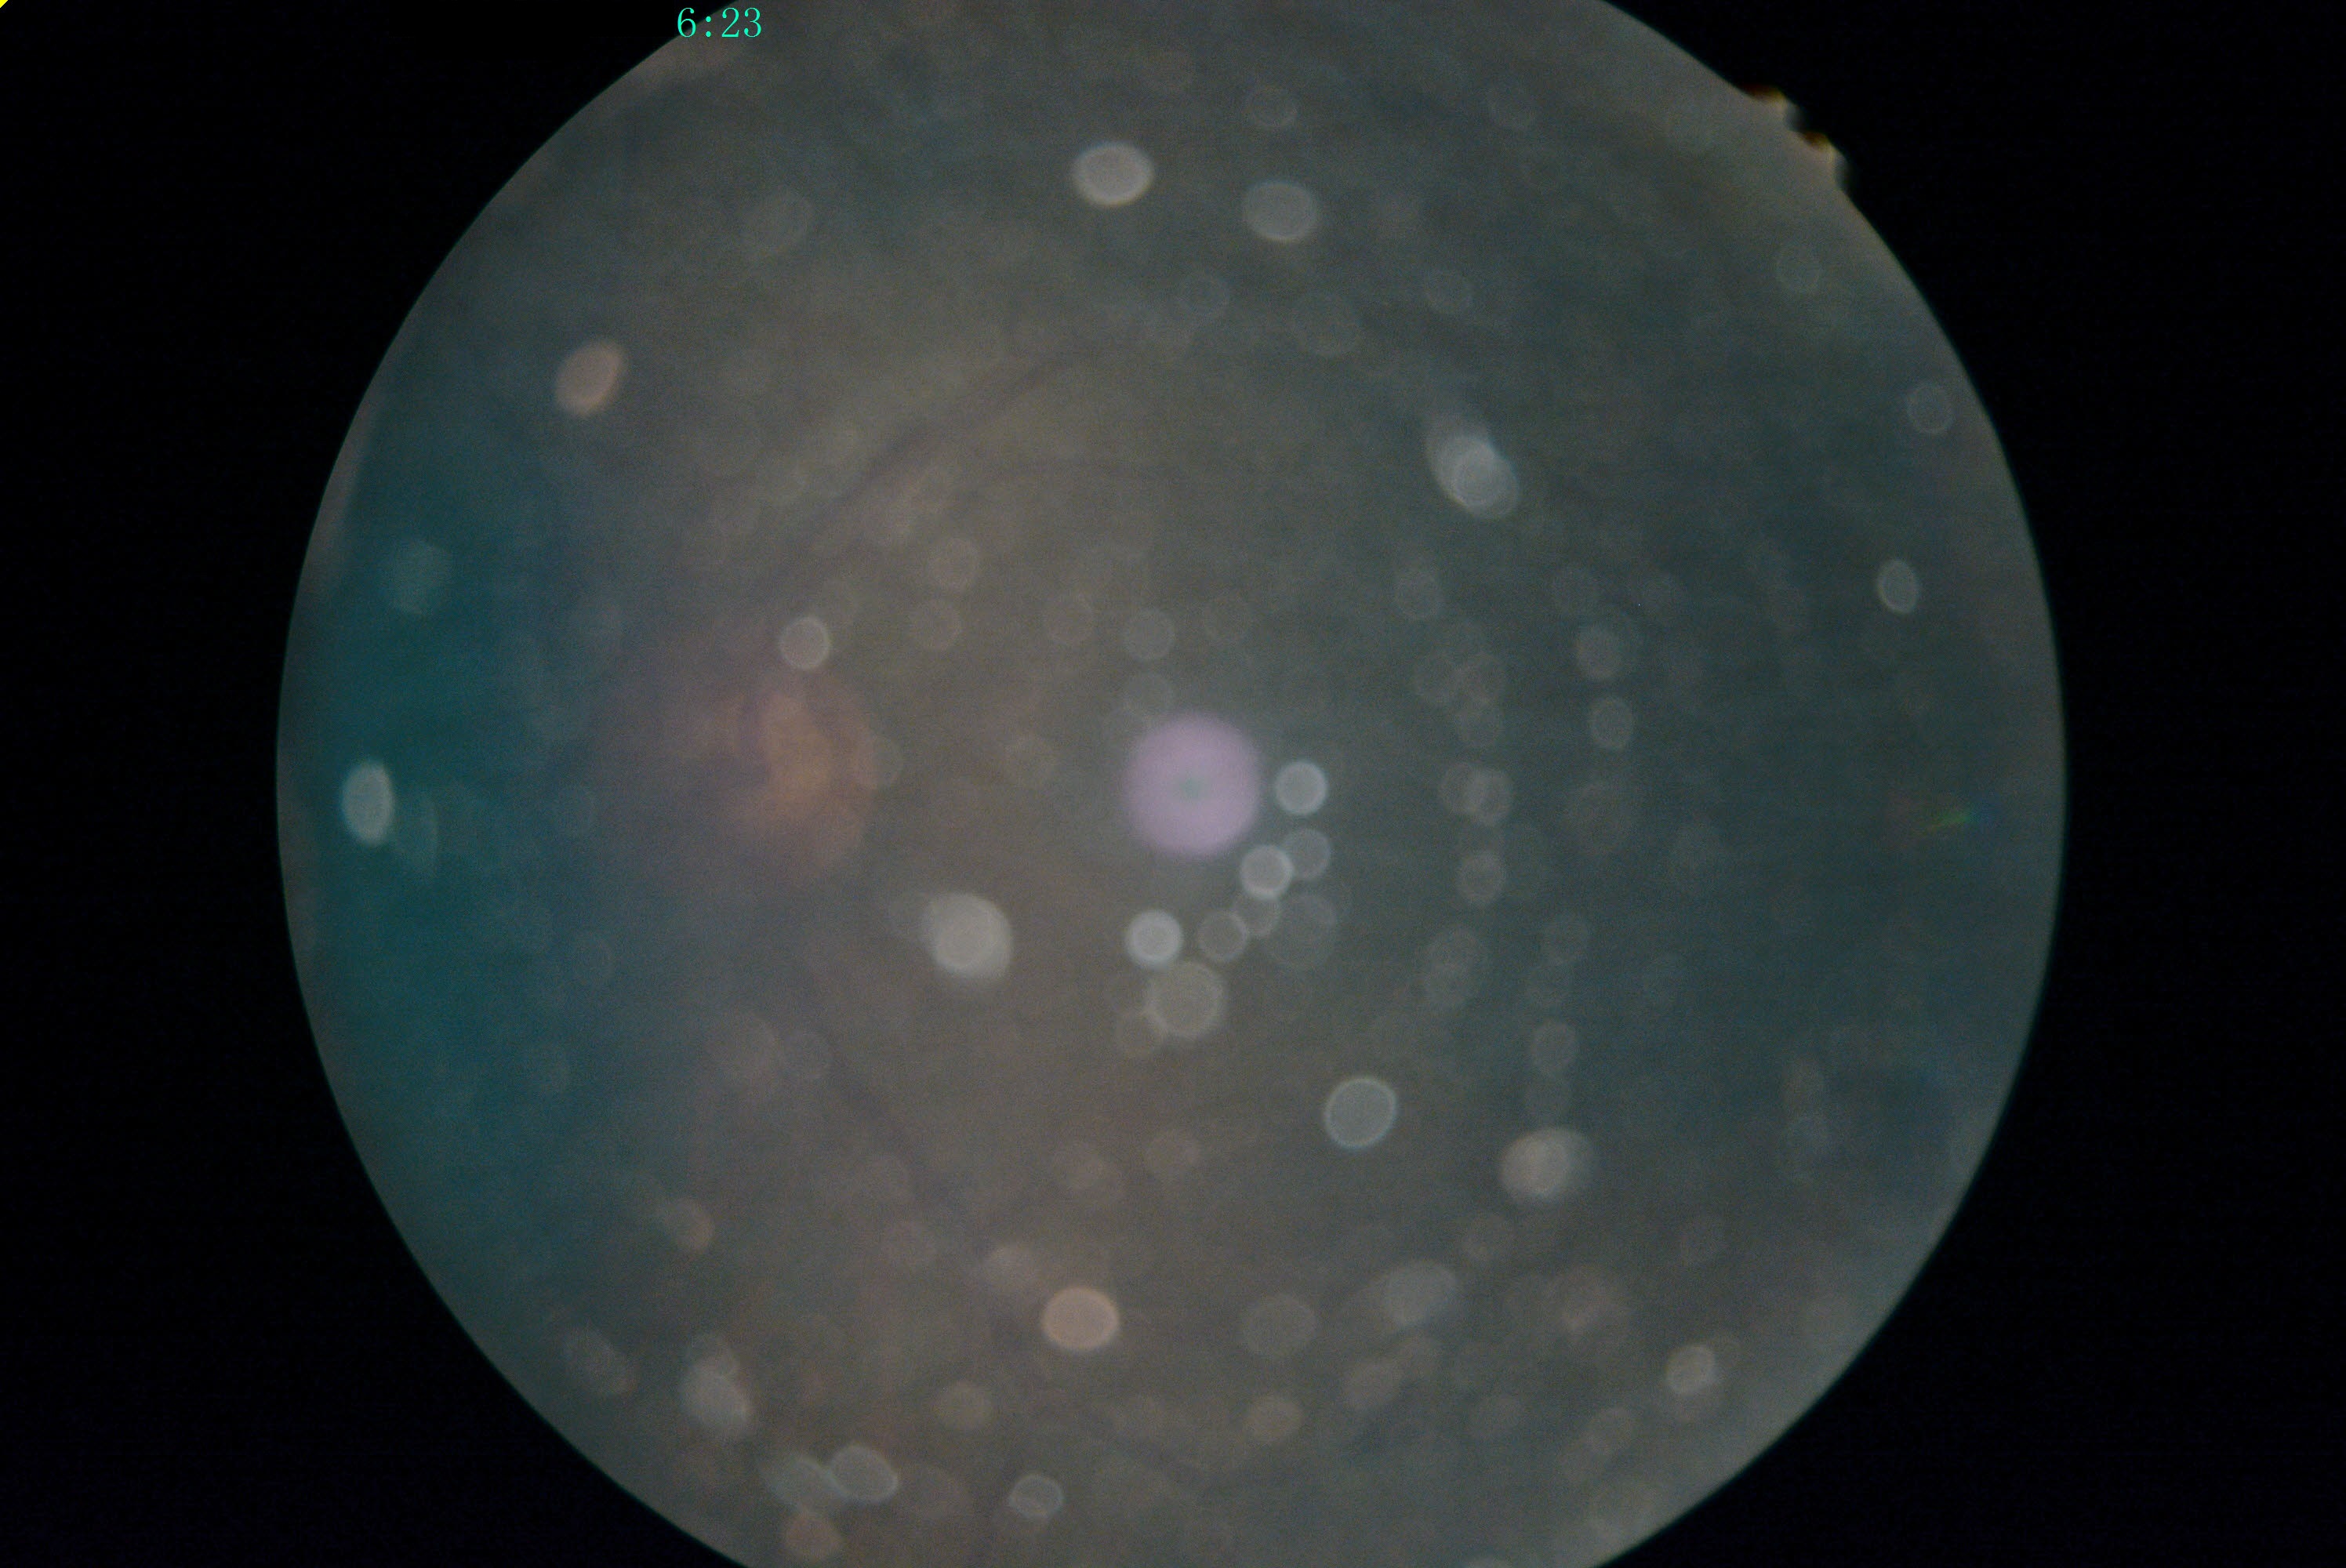 Retinopathy grade: ungradable.